Infant wide-field retinal image — 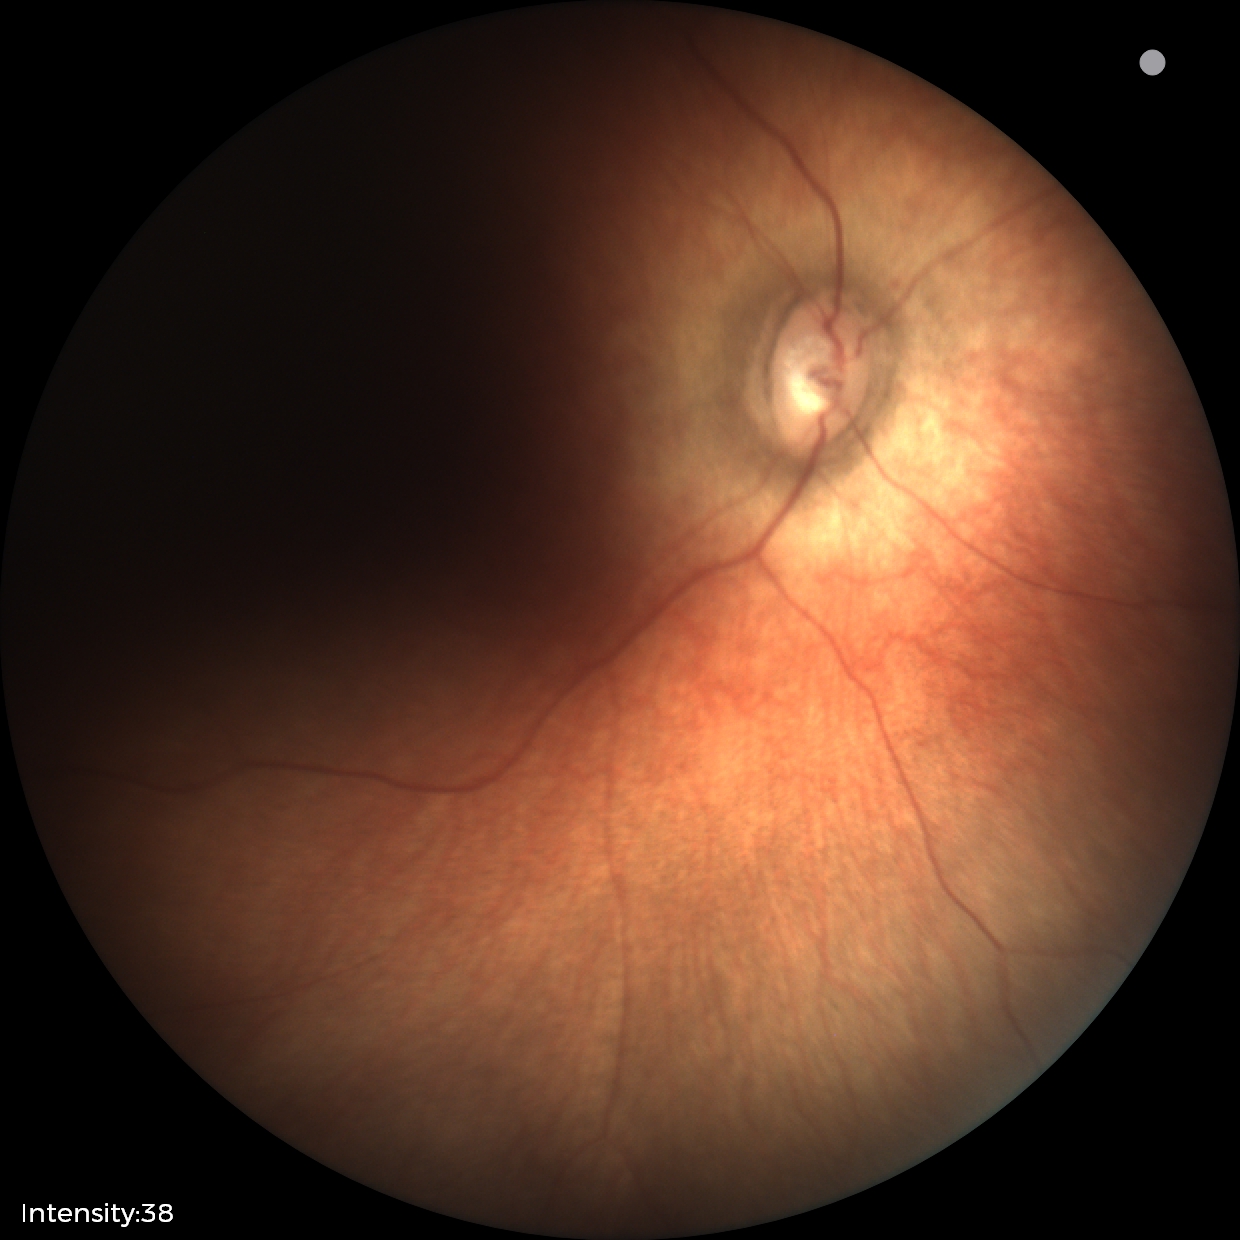 Impression: normal fundus examination.